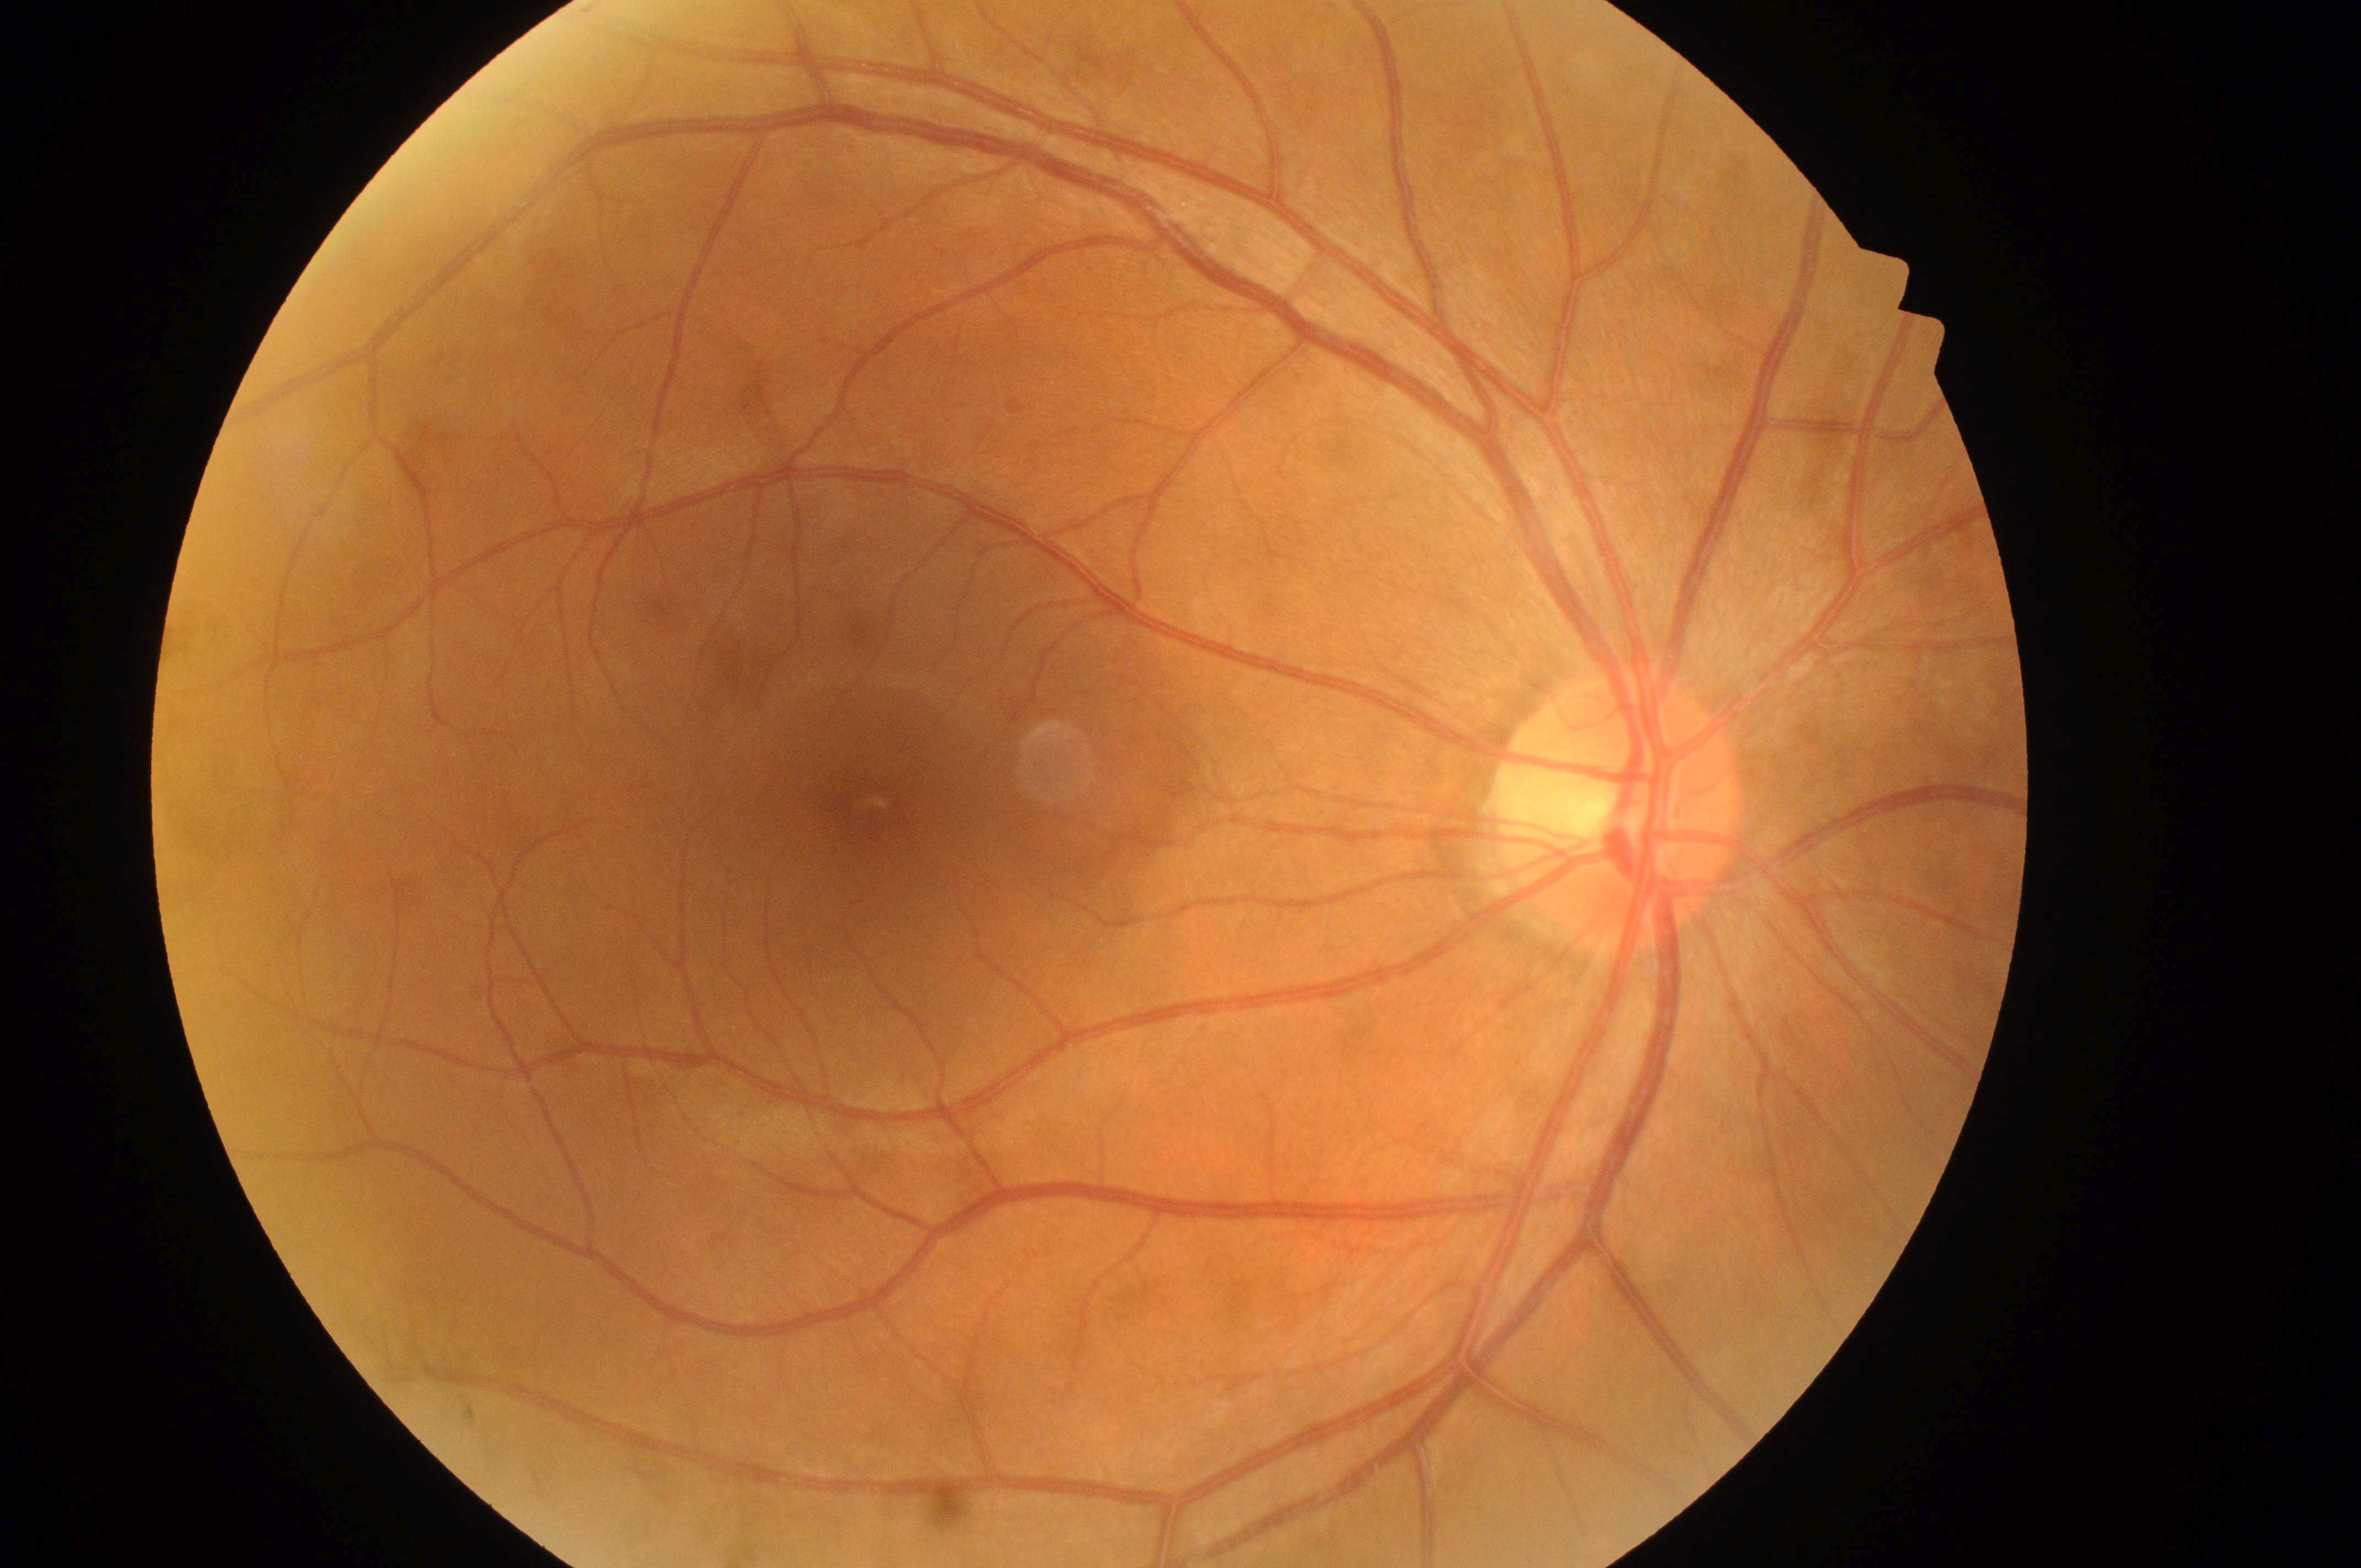
Annotations:
• diabetic retinopathy (DR) · no apparent diabetic retinopathy (grade 0)
• diabetic macular edema (DME) · no risk (grade 0)
• disc center · (1615,818)
• laterality · the right eye
• fovea center · (868,802)